Nonmydriatic, 848x848, Davis DR grading, acquired with a NIDEK AFC-230, CFP
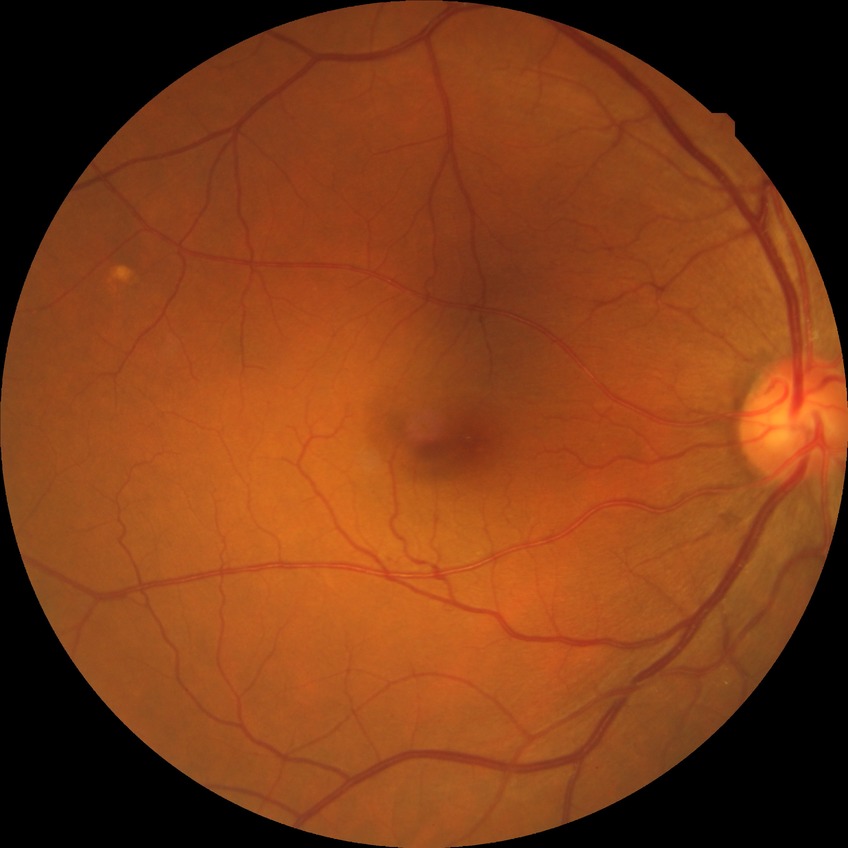
* diabetic retinopathy (DR) — NDR (no diabetic retinopathy)